Optic disc-centered crop:
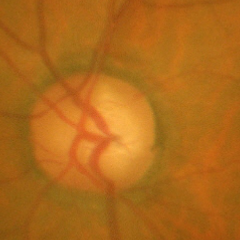 Fundus appearance consistent with advanced-stage glaucoma.